DR severity per modified Davis staging:
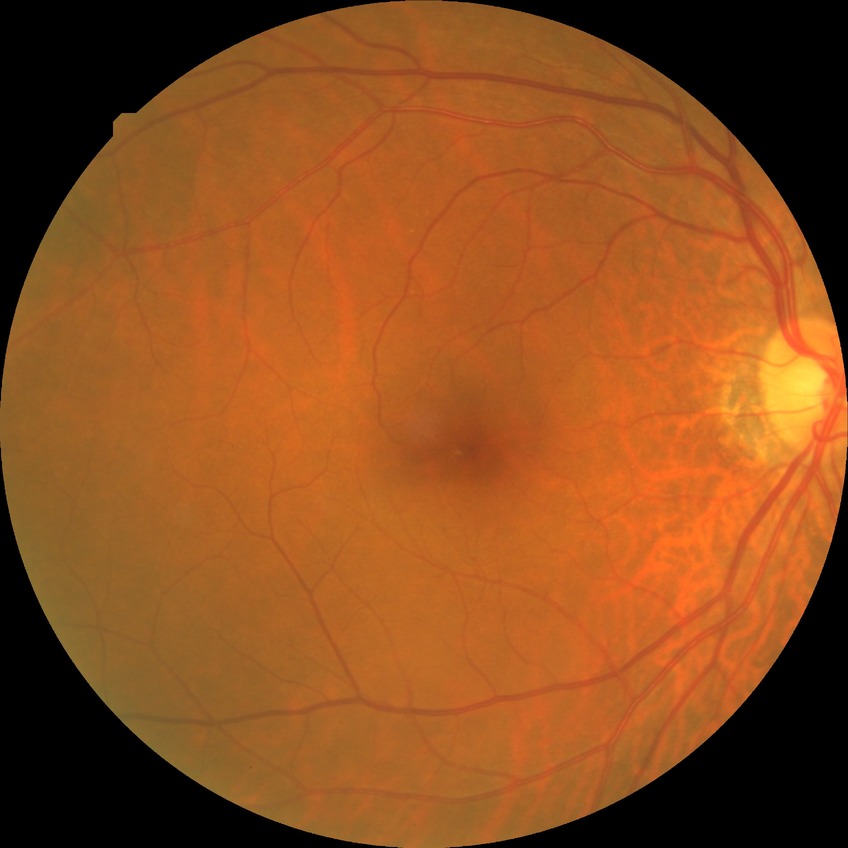
DR stage: SDR.